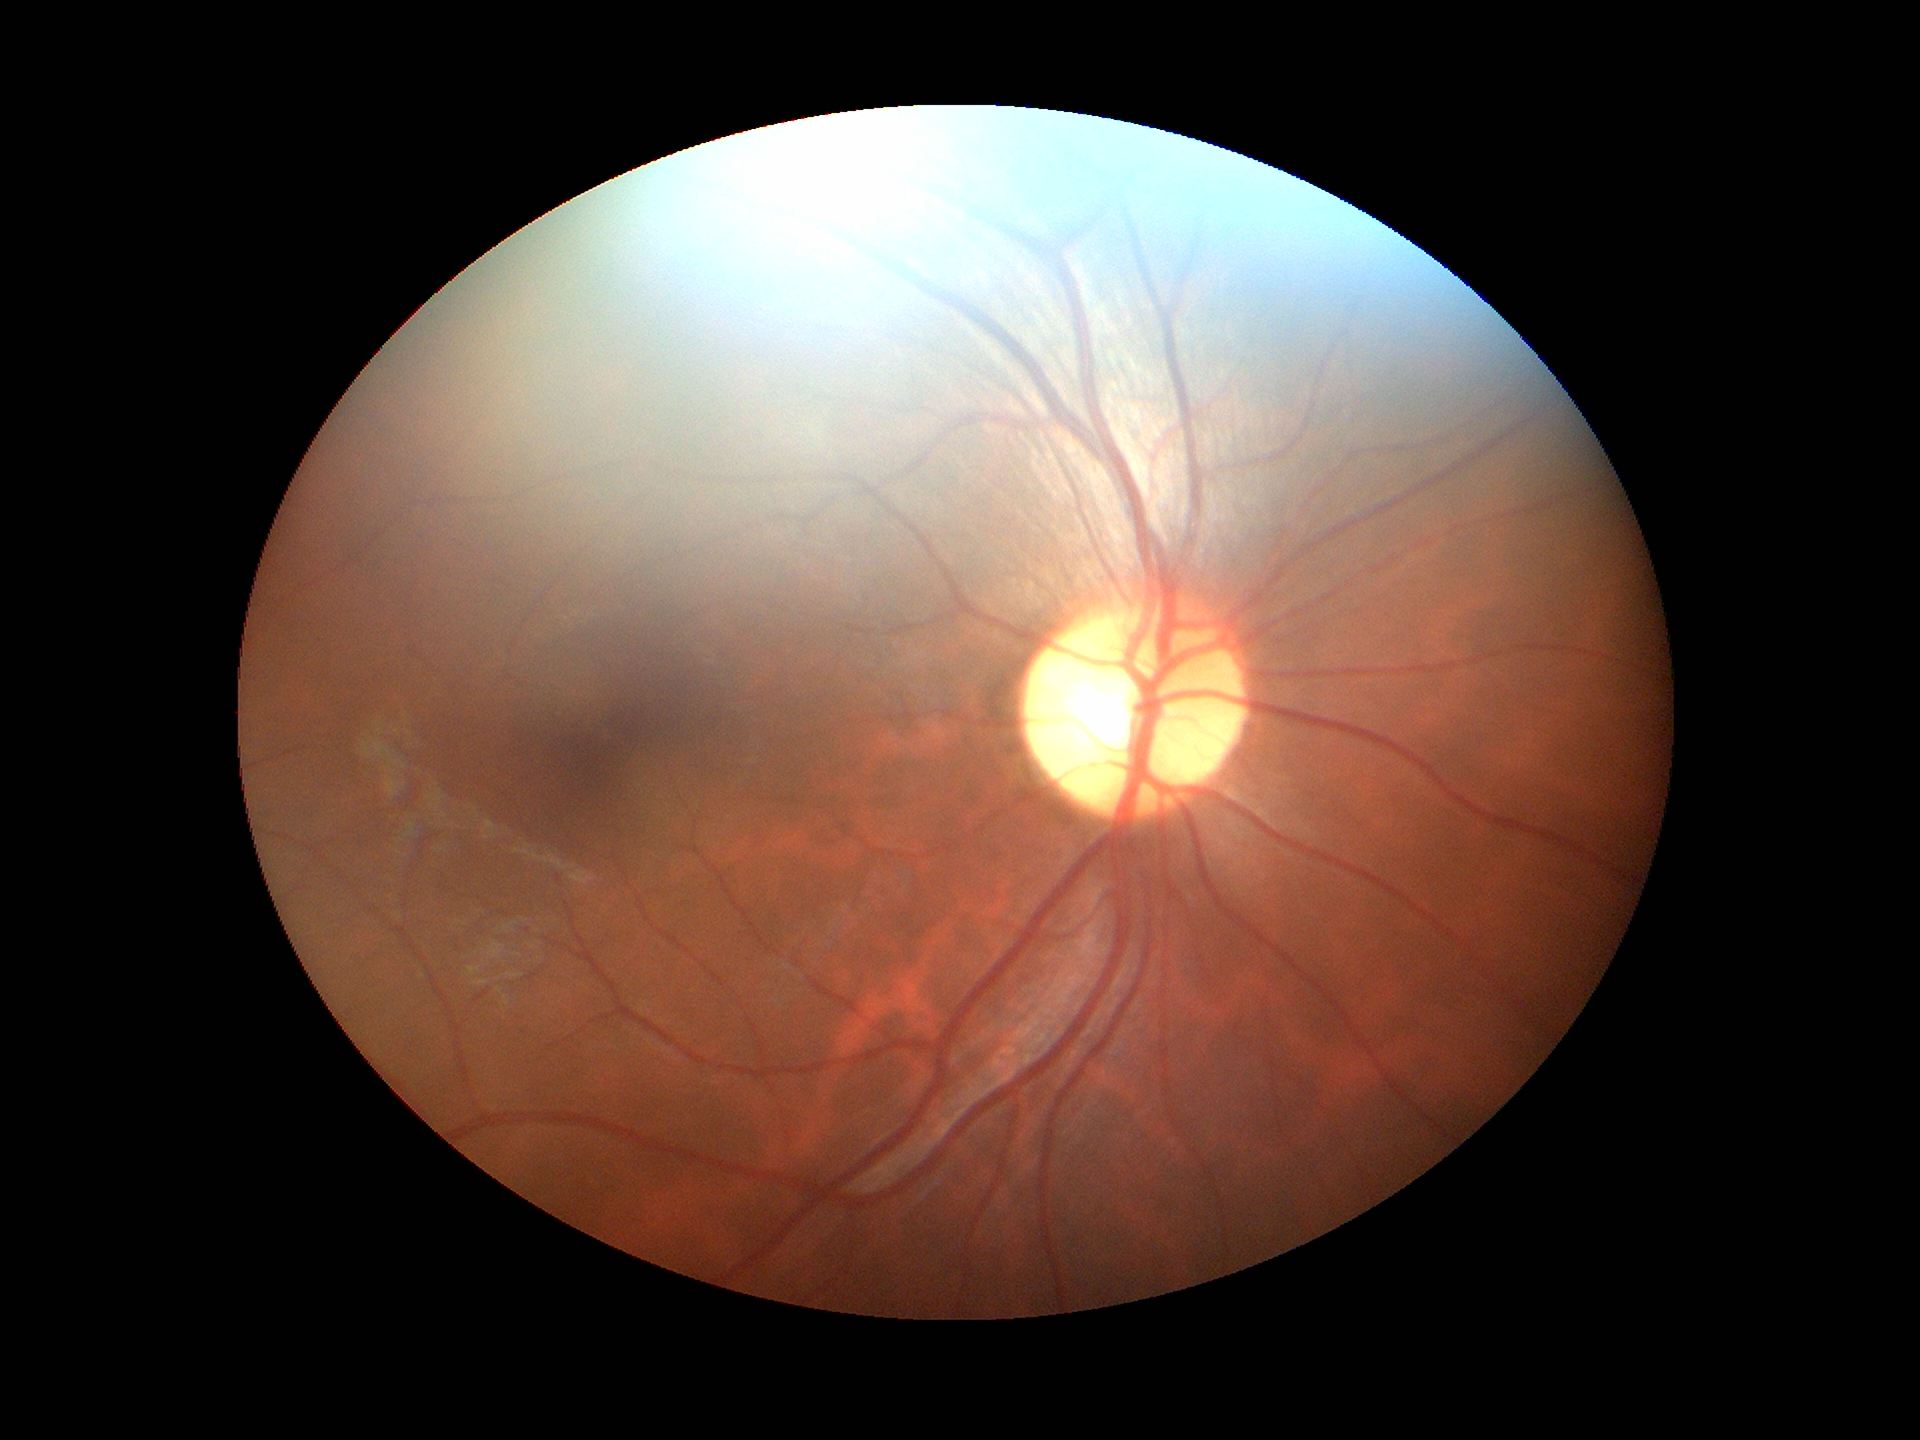

horizontal cup-to-disc ratio: 0.52, Glaucoma screening impression: not suspect, vertical cup-disc ratio: 0.56.